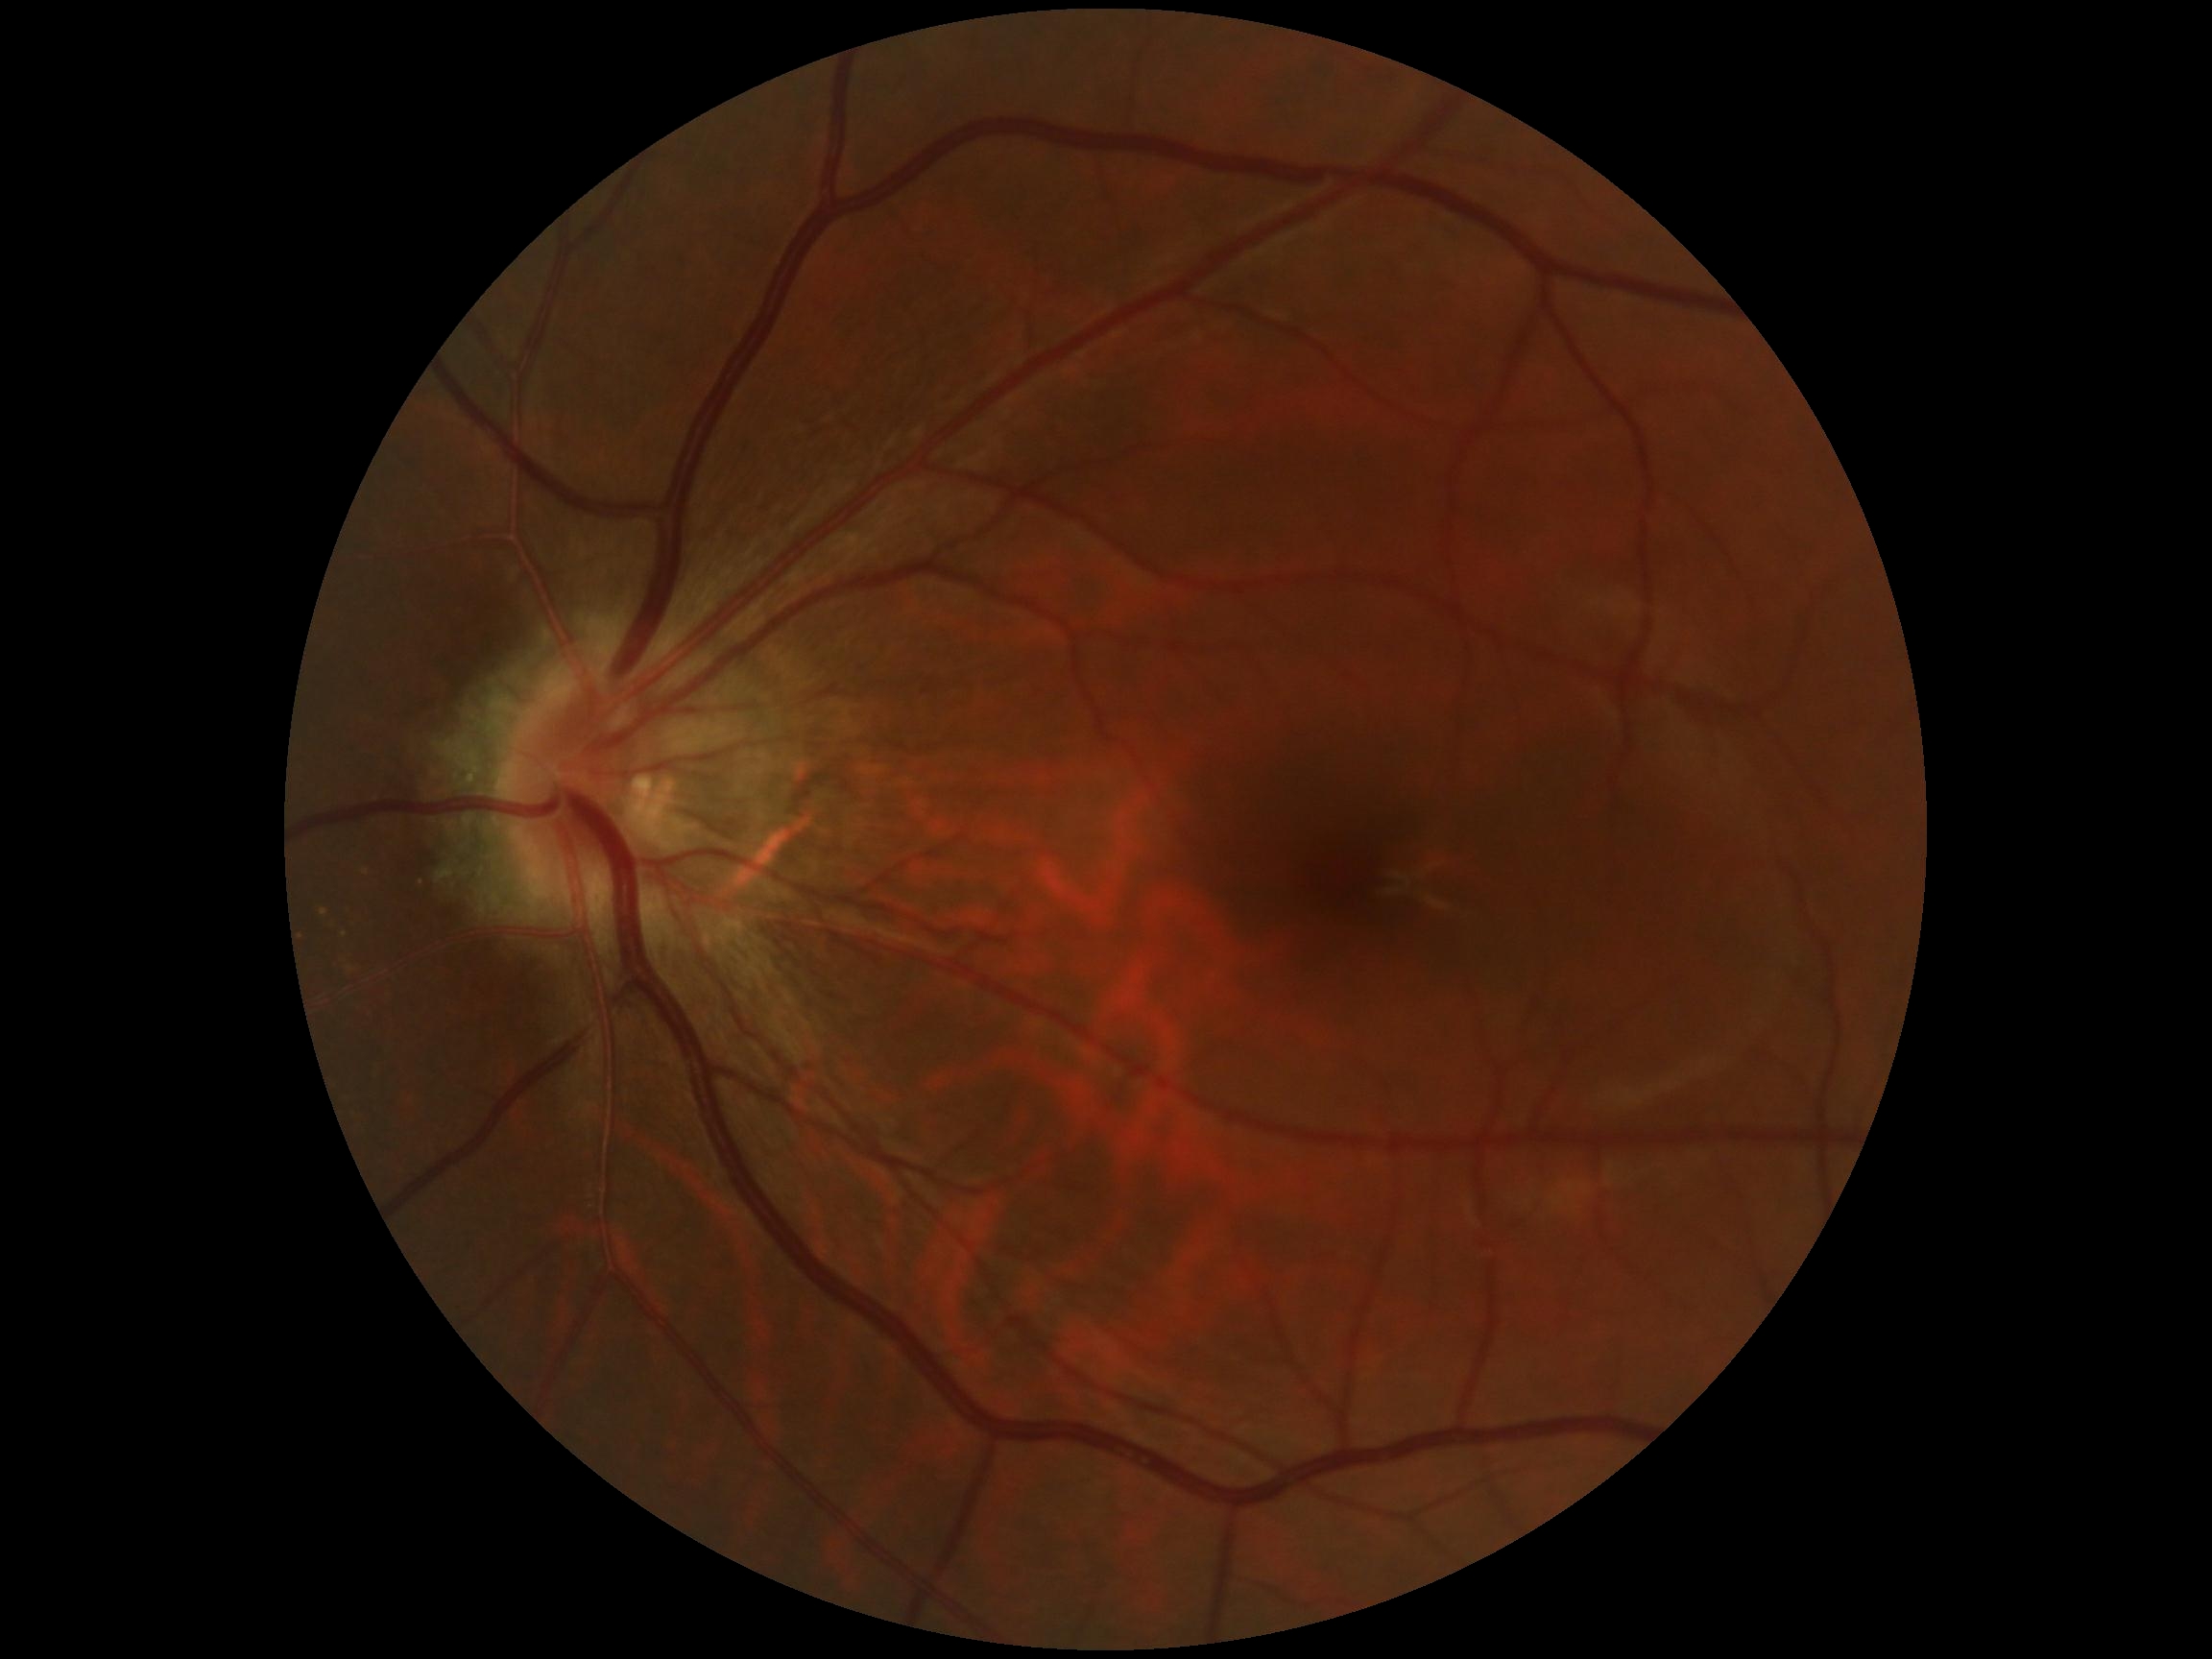 No diabetic retinal disease findings. Retinopathy: grade 0 (no apparent retinopathy).